2212x1659px
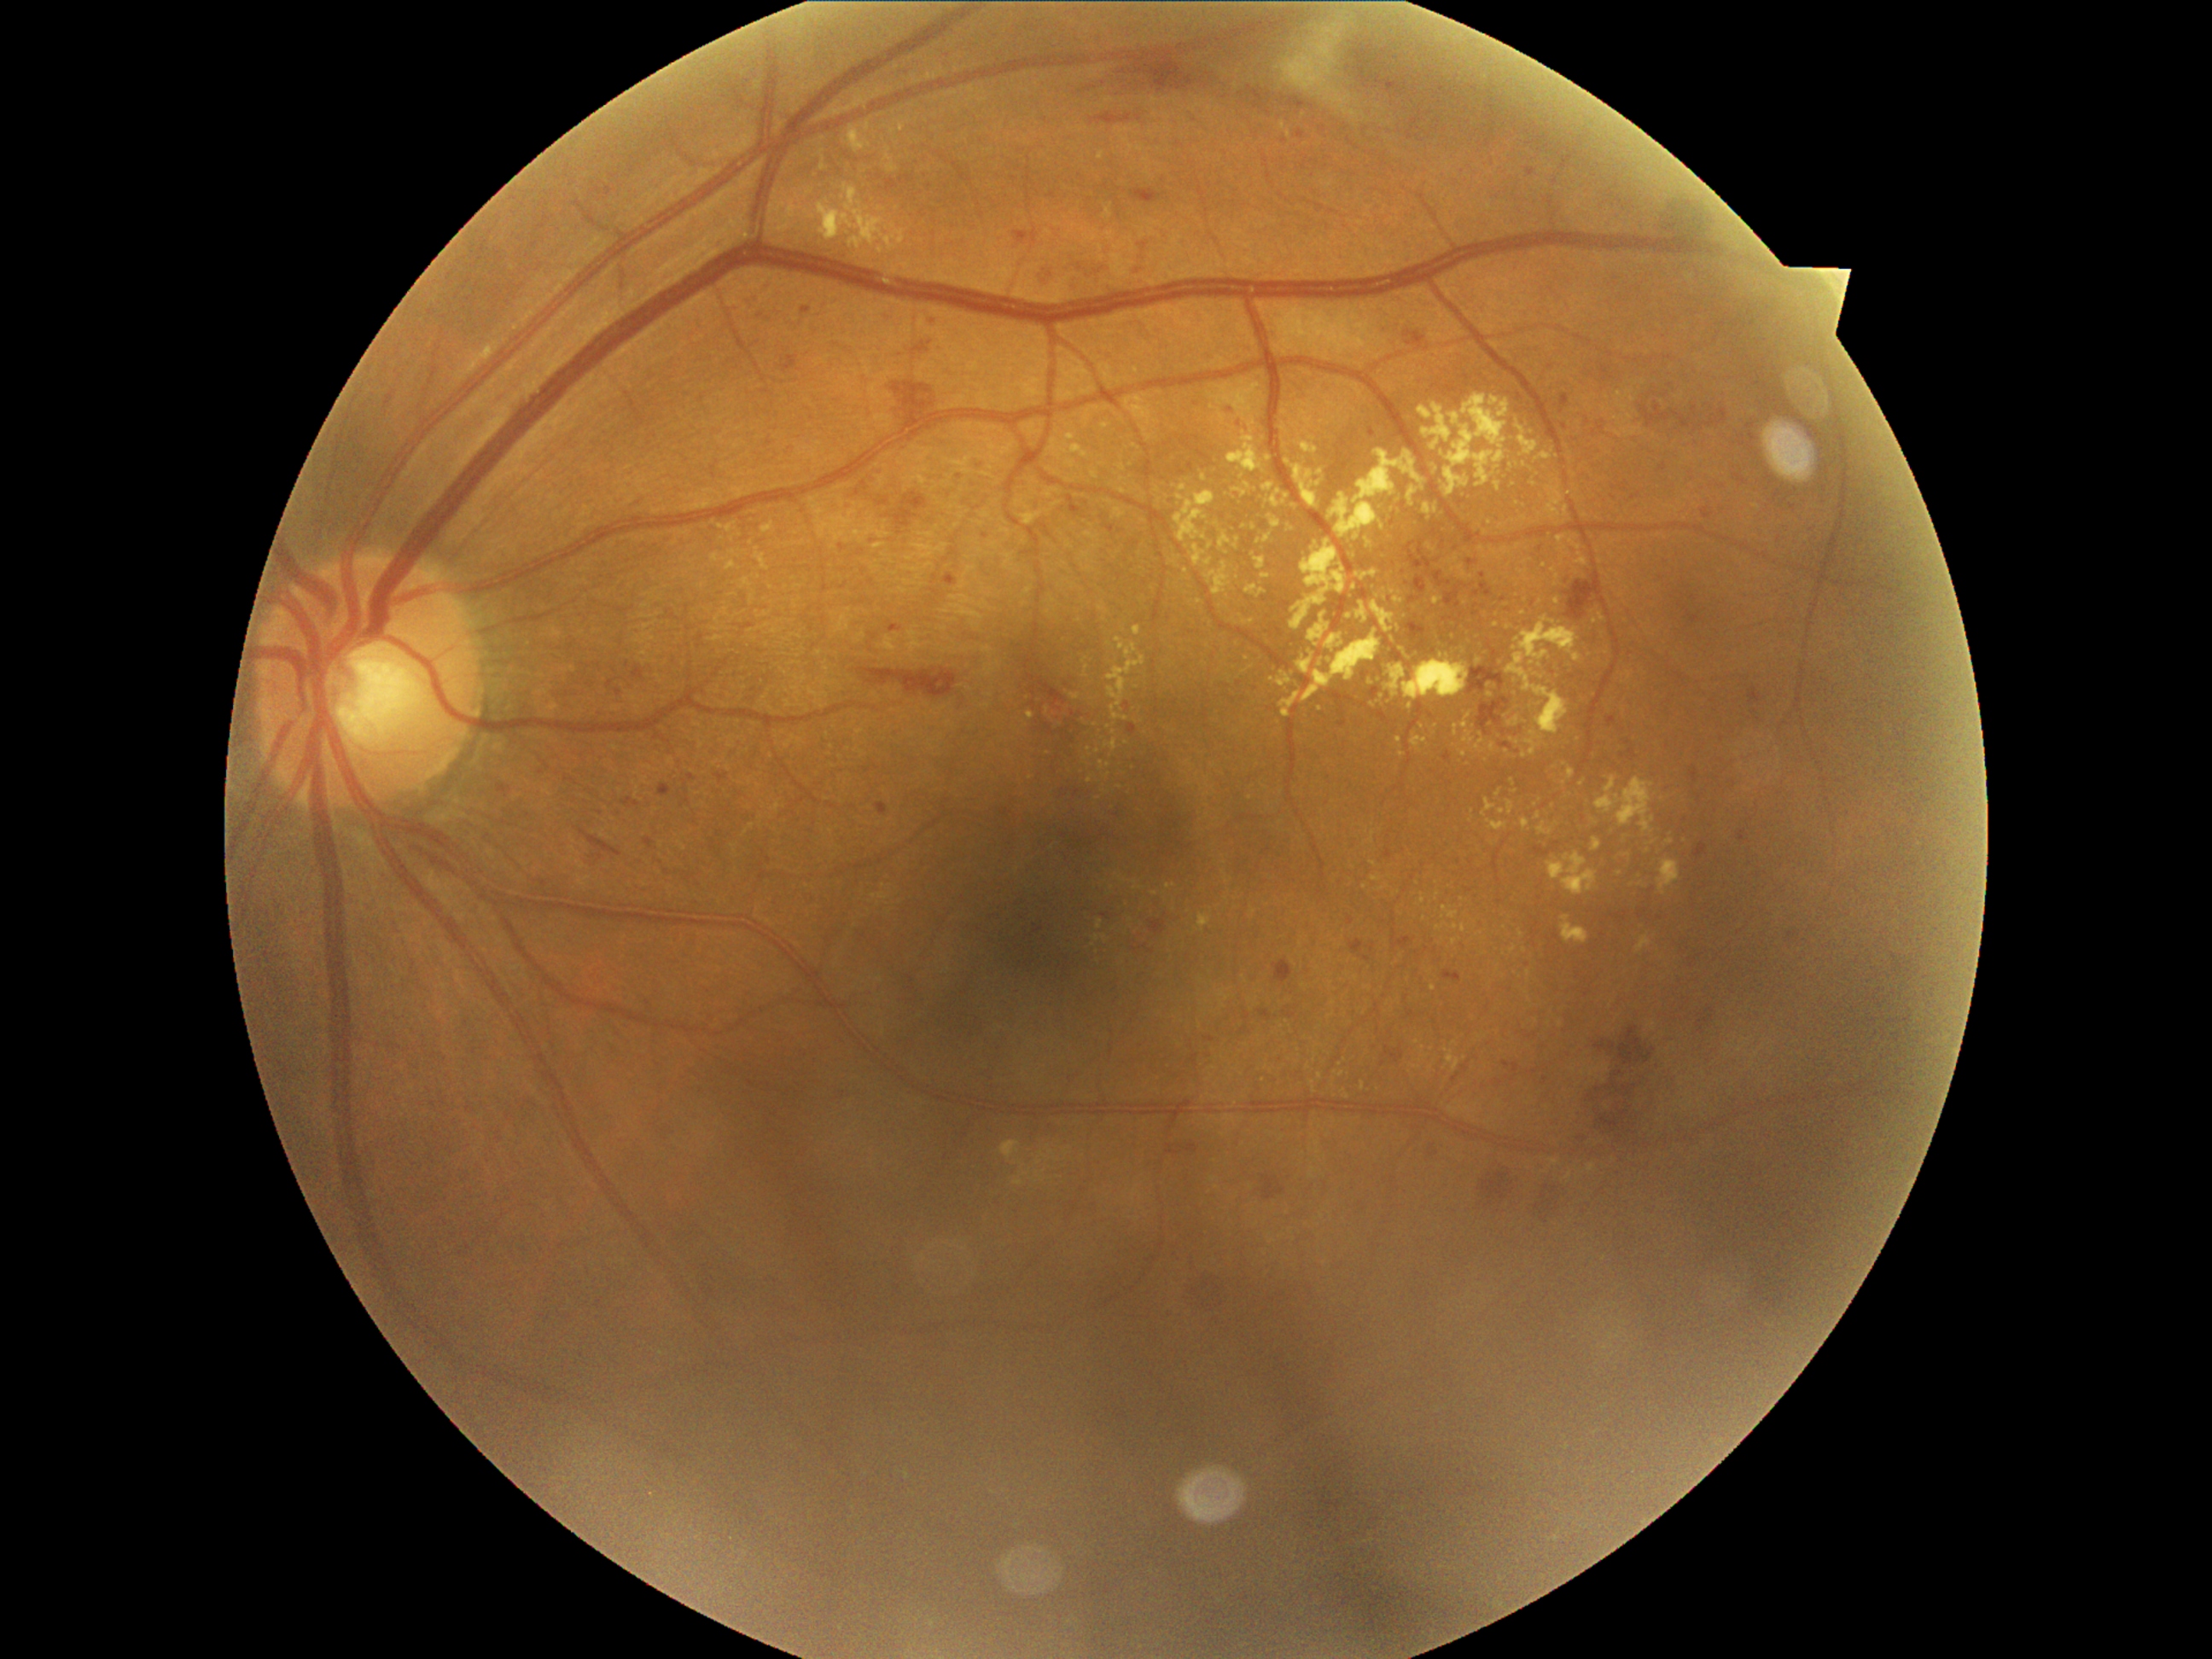 <lesions partial="true">
  <dr_grade>2</dr_grade>
  <ex partial="true">849, 127, 871, 153 | 1394, 598, 1404, 605 | 1593, 837, 1604, 853 | 1175, 491, 1216, 542 | 873, 544, 885, 550 | 1245, 585, 1266, 598 | 1371, 696, 1387, 709 | 1491, 549, 1498, 557 | 1520, 569, 1528, 581 | 1361, 1083, 1365, 1091</ex>
  <ex_small_centers>(1525, 951) | (1355, 588) | (1524, 614) | (1136, 881) | (1525, 757) | (1562, 561) | (1086, 669) | (1321, 1076) | (1438, 896)</ex_small_centers>
</lesions>